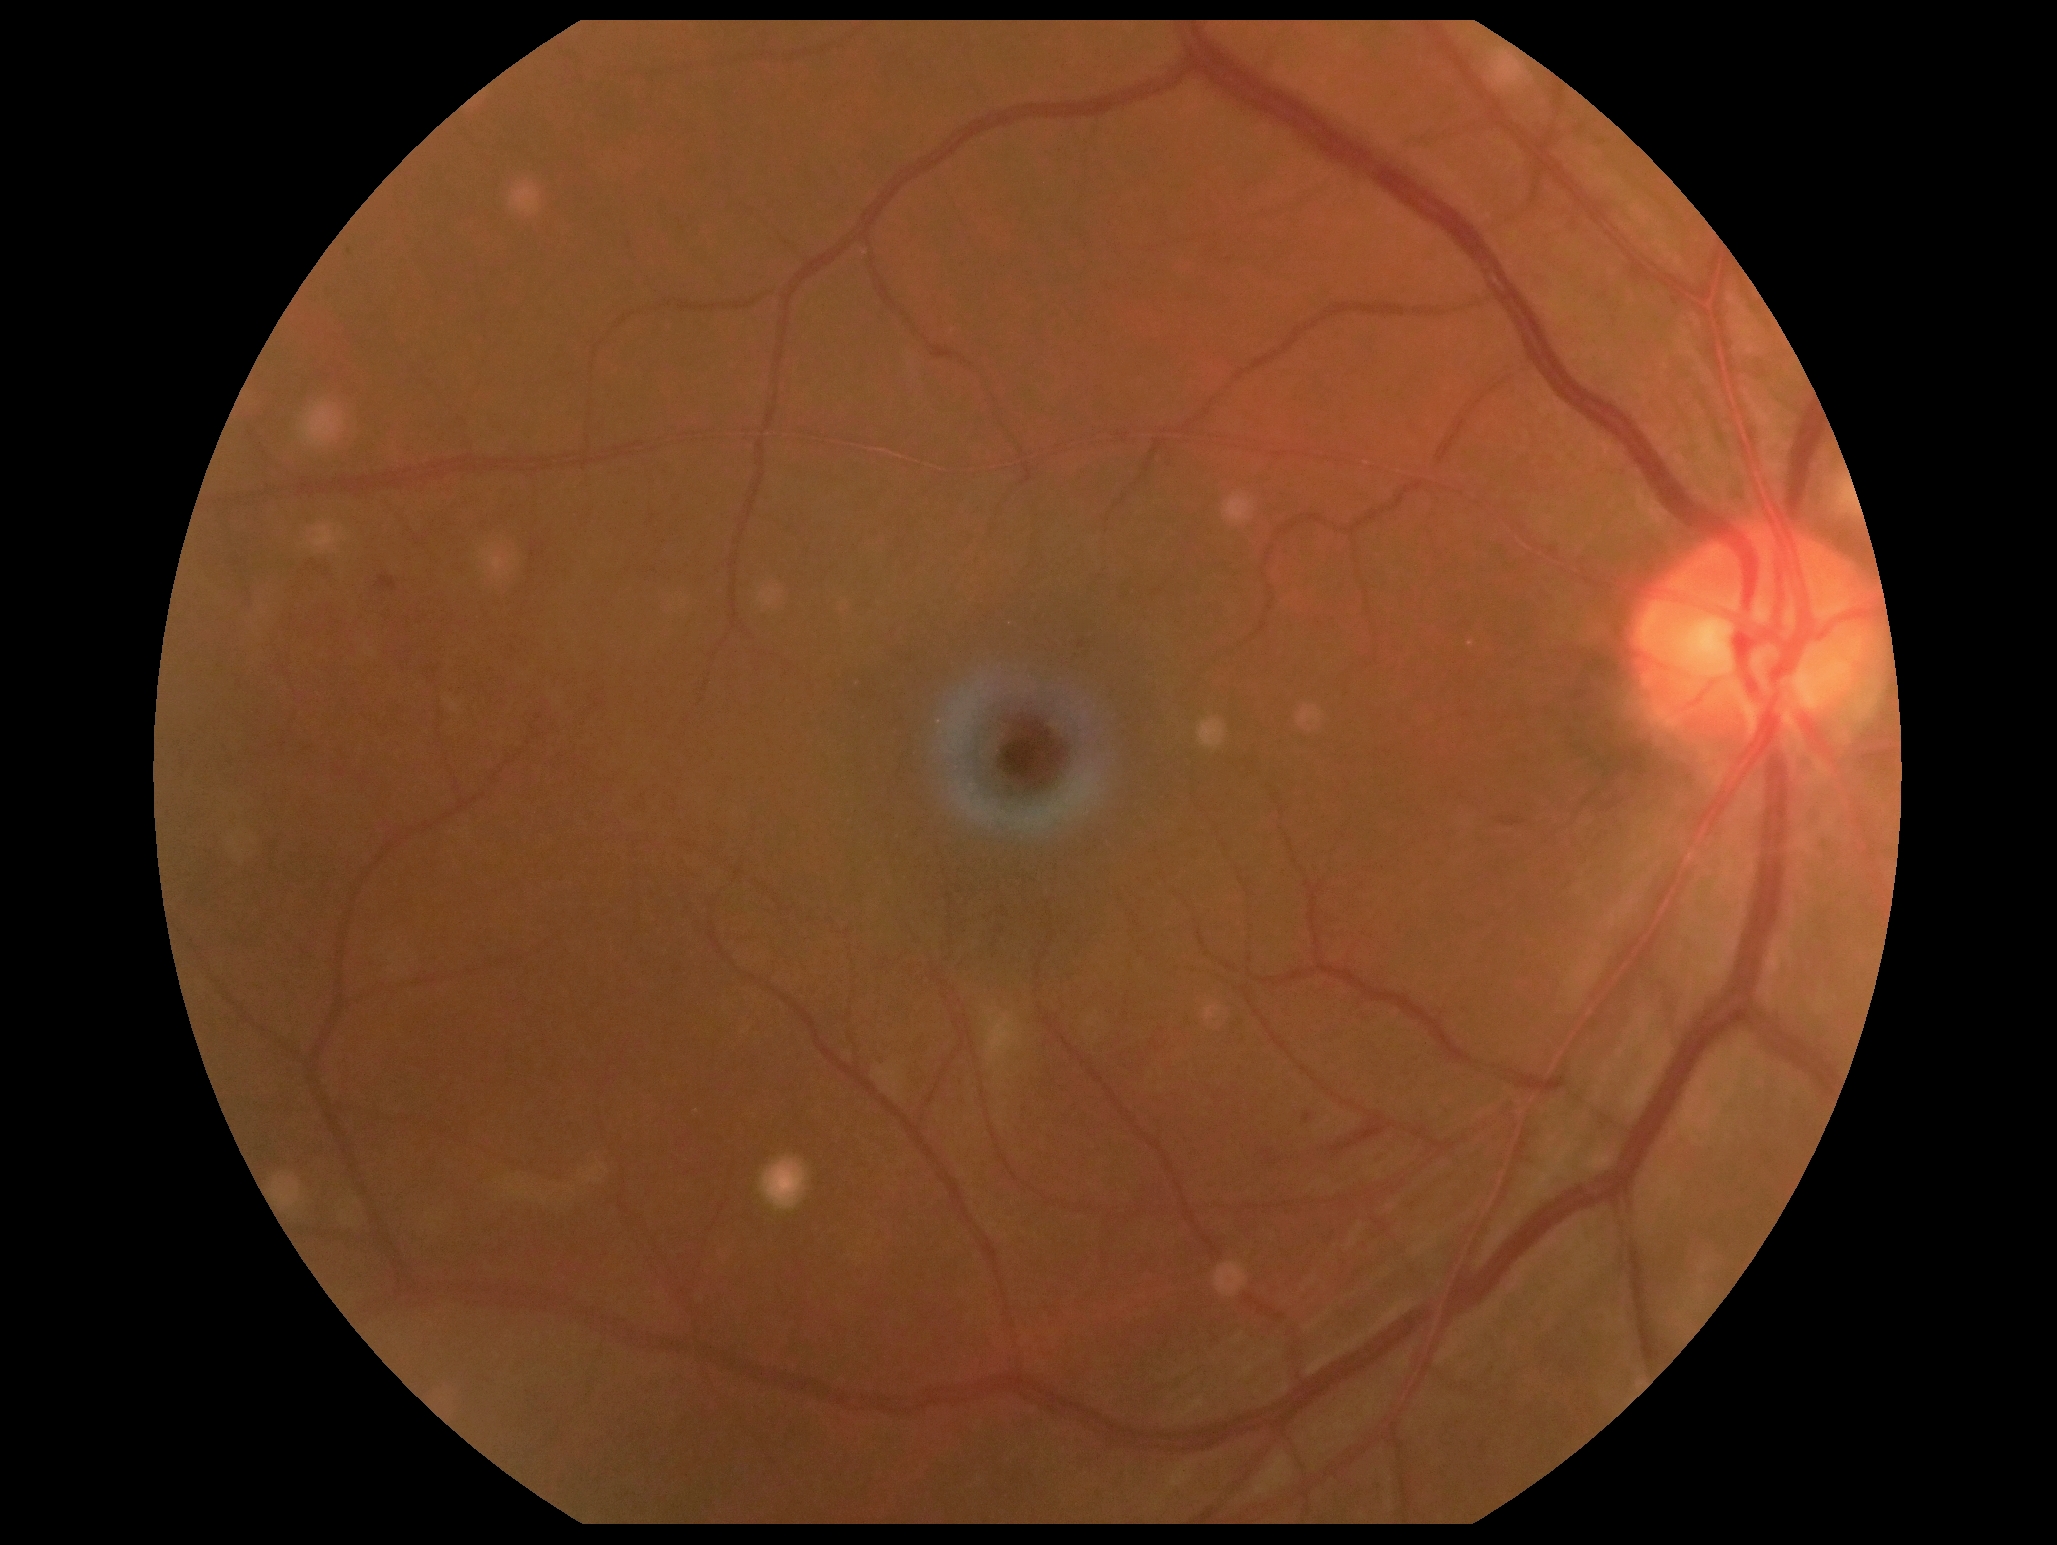
Findings:
- diabetic retinopathy (DR) — grade 2 (moderate NPDR) — more than just microaneurysms but less than severe NPDR
- DR class — non-proliferative diabetic retinopathy